Wide-field fundus photograph of an infant — 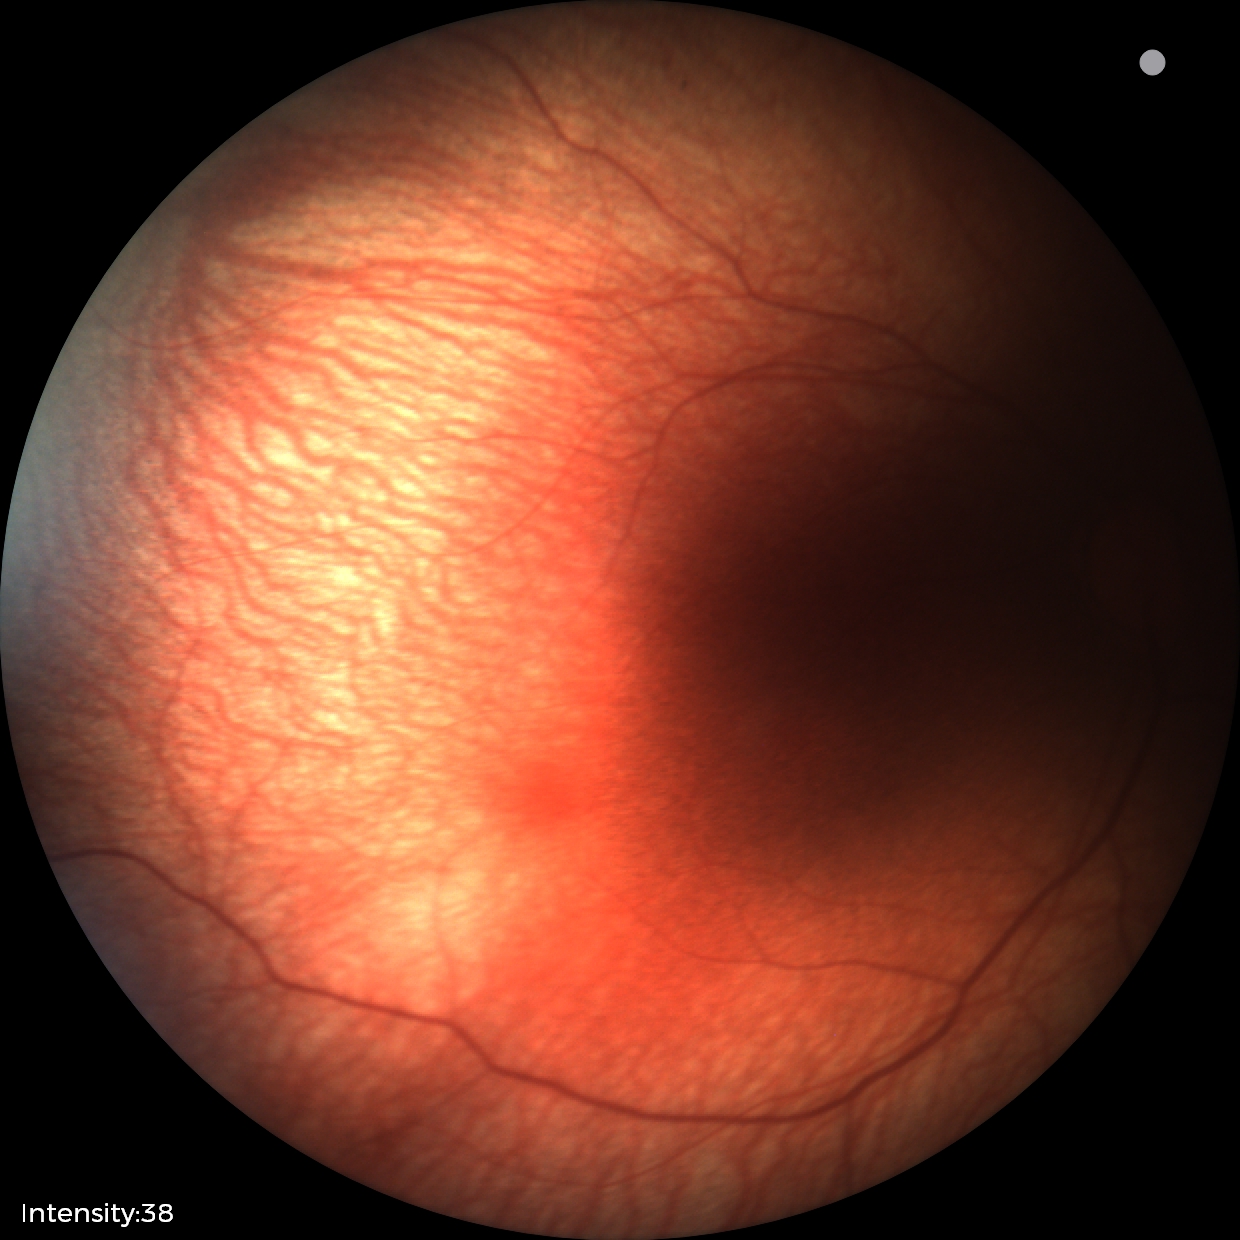

Physiological retinal appearance for postconceptual age.